Camera: Clarity RetCam 3 (130° FOV) · RetCam wide-field infant fundus image — 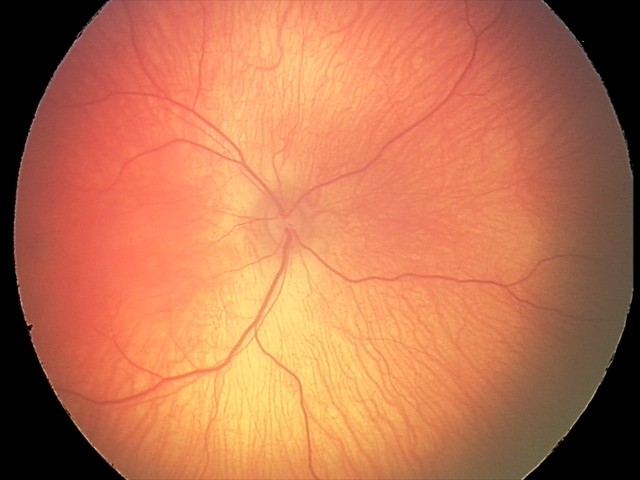
Physiological retinal appearance for postconceptual age.